2048 x 1536 pixels: 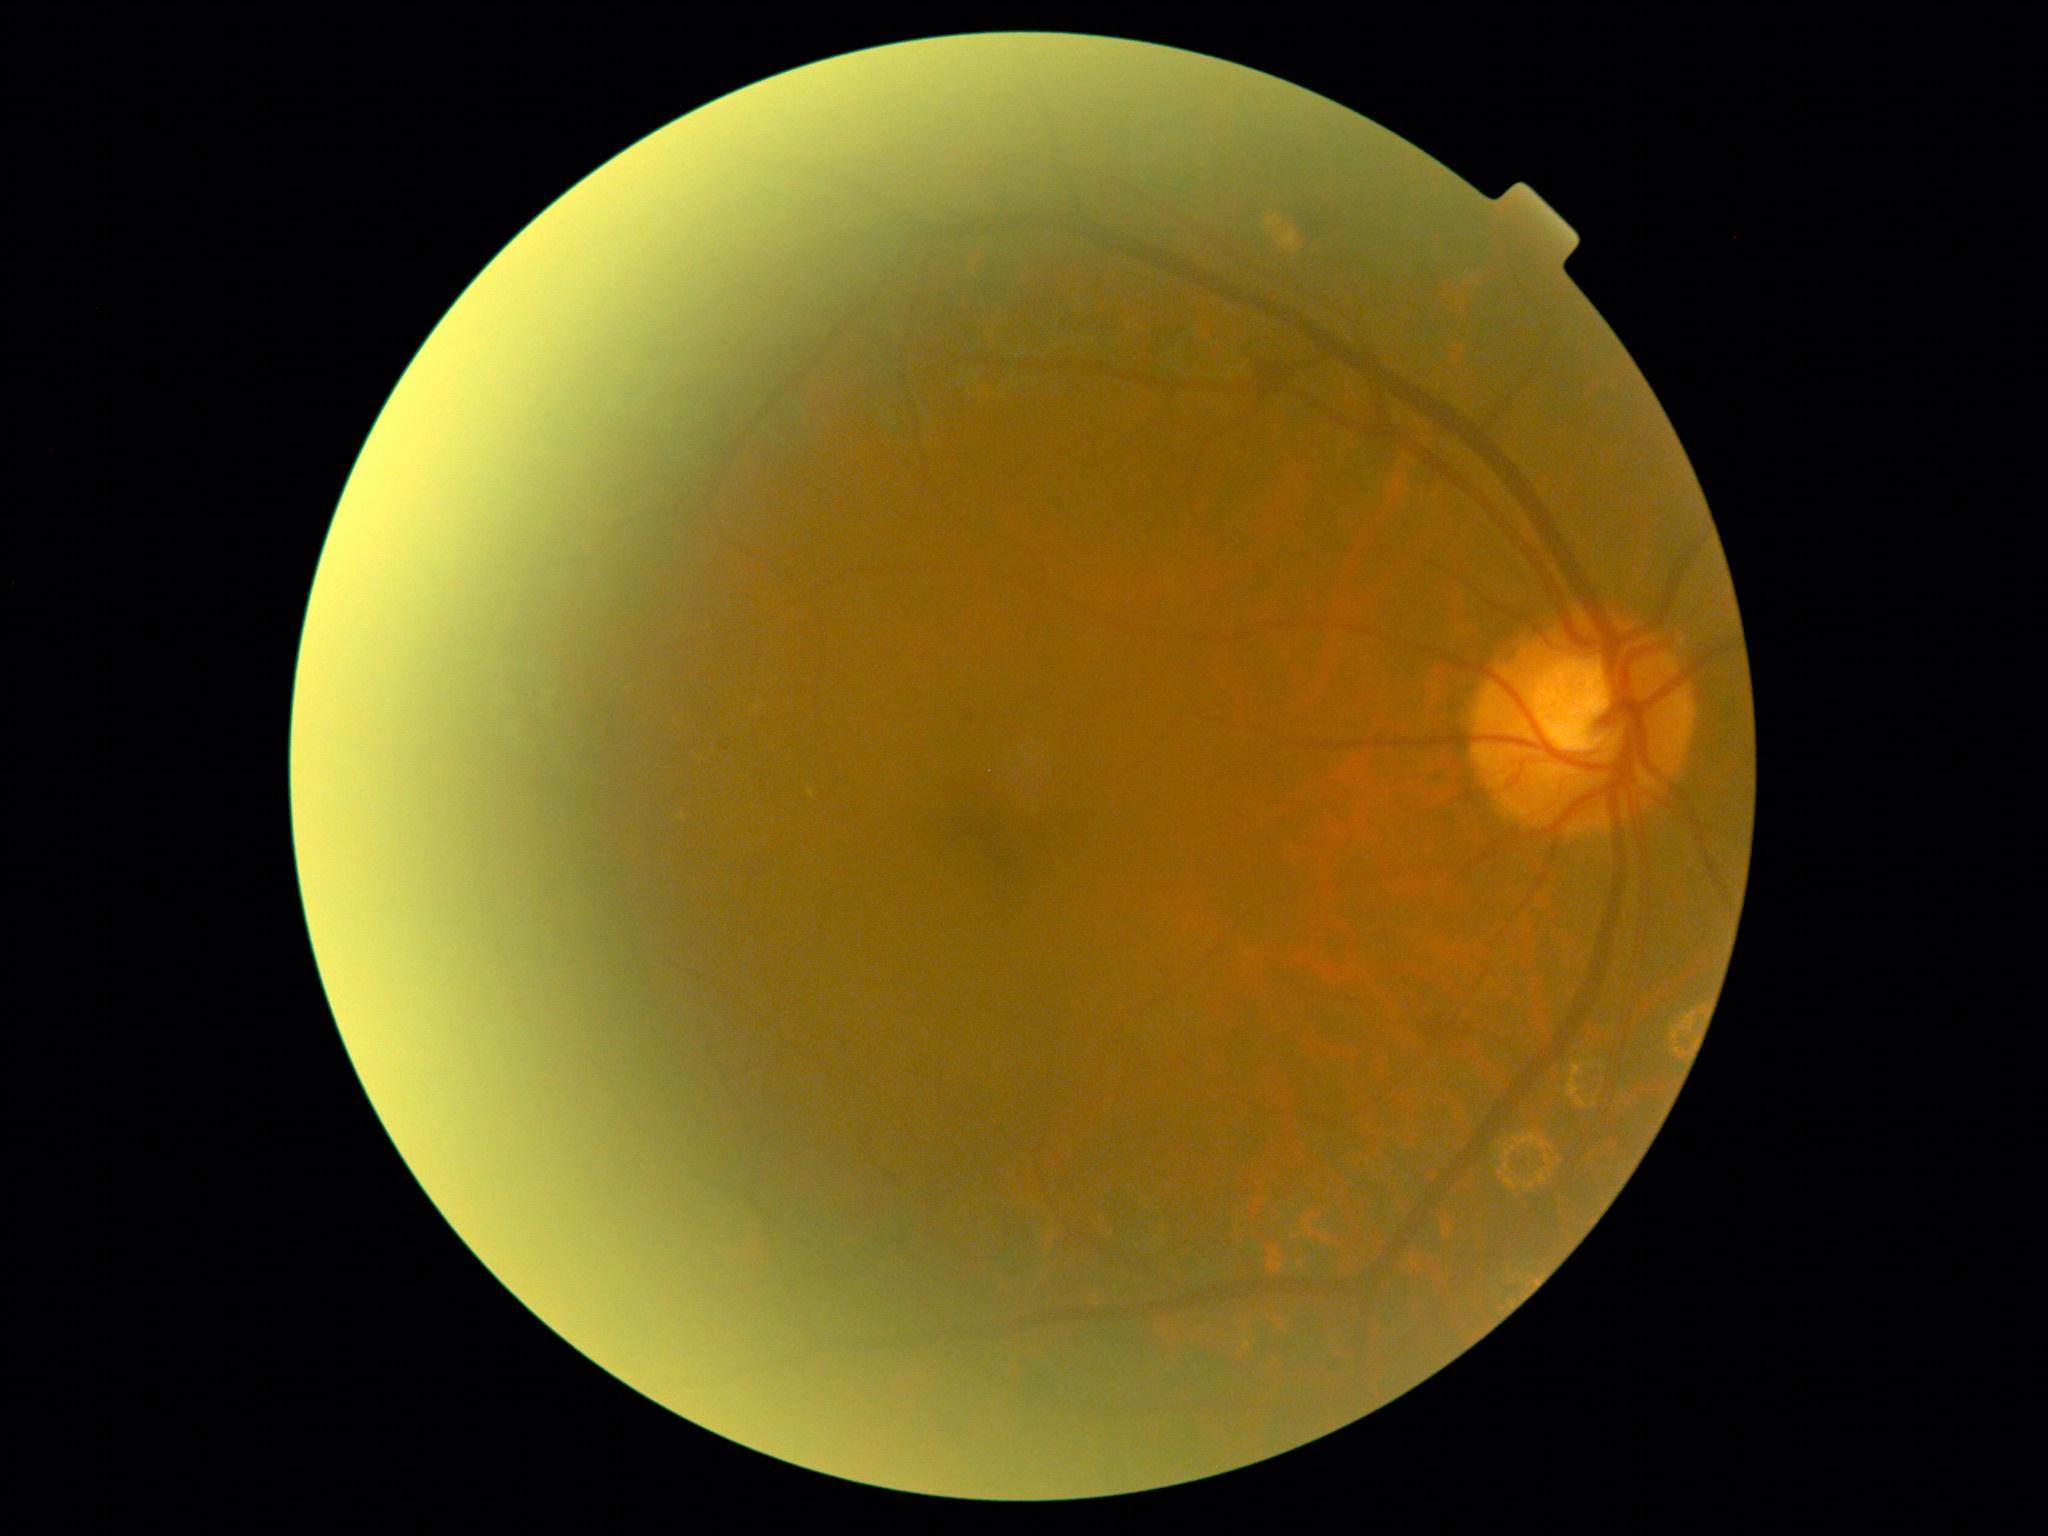
Diabetic retinopathy severity: moderate non-proliferative diabetic retinopathy (grade 2).